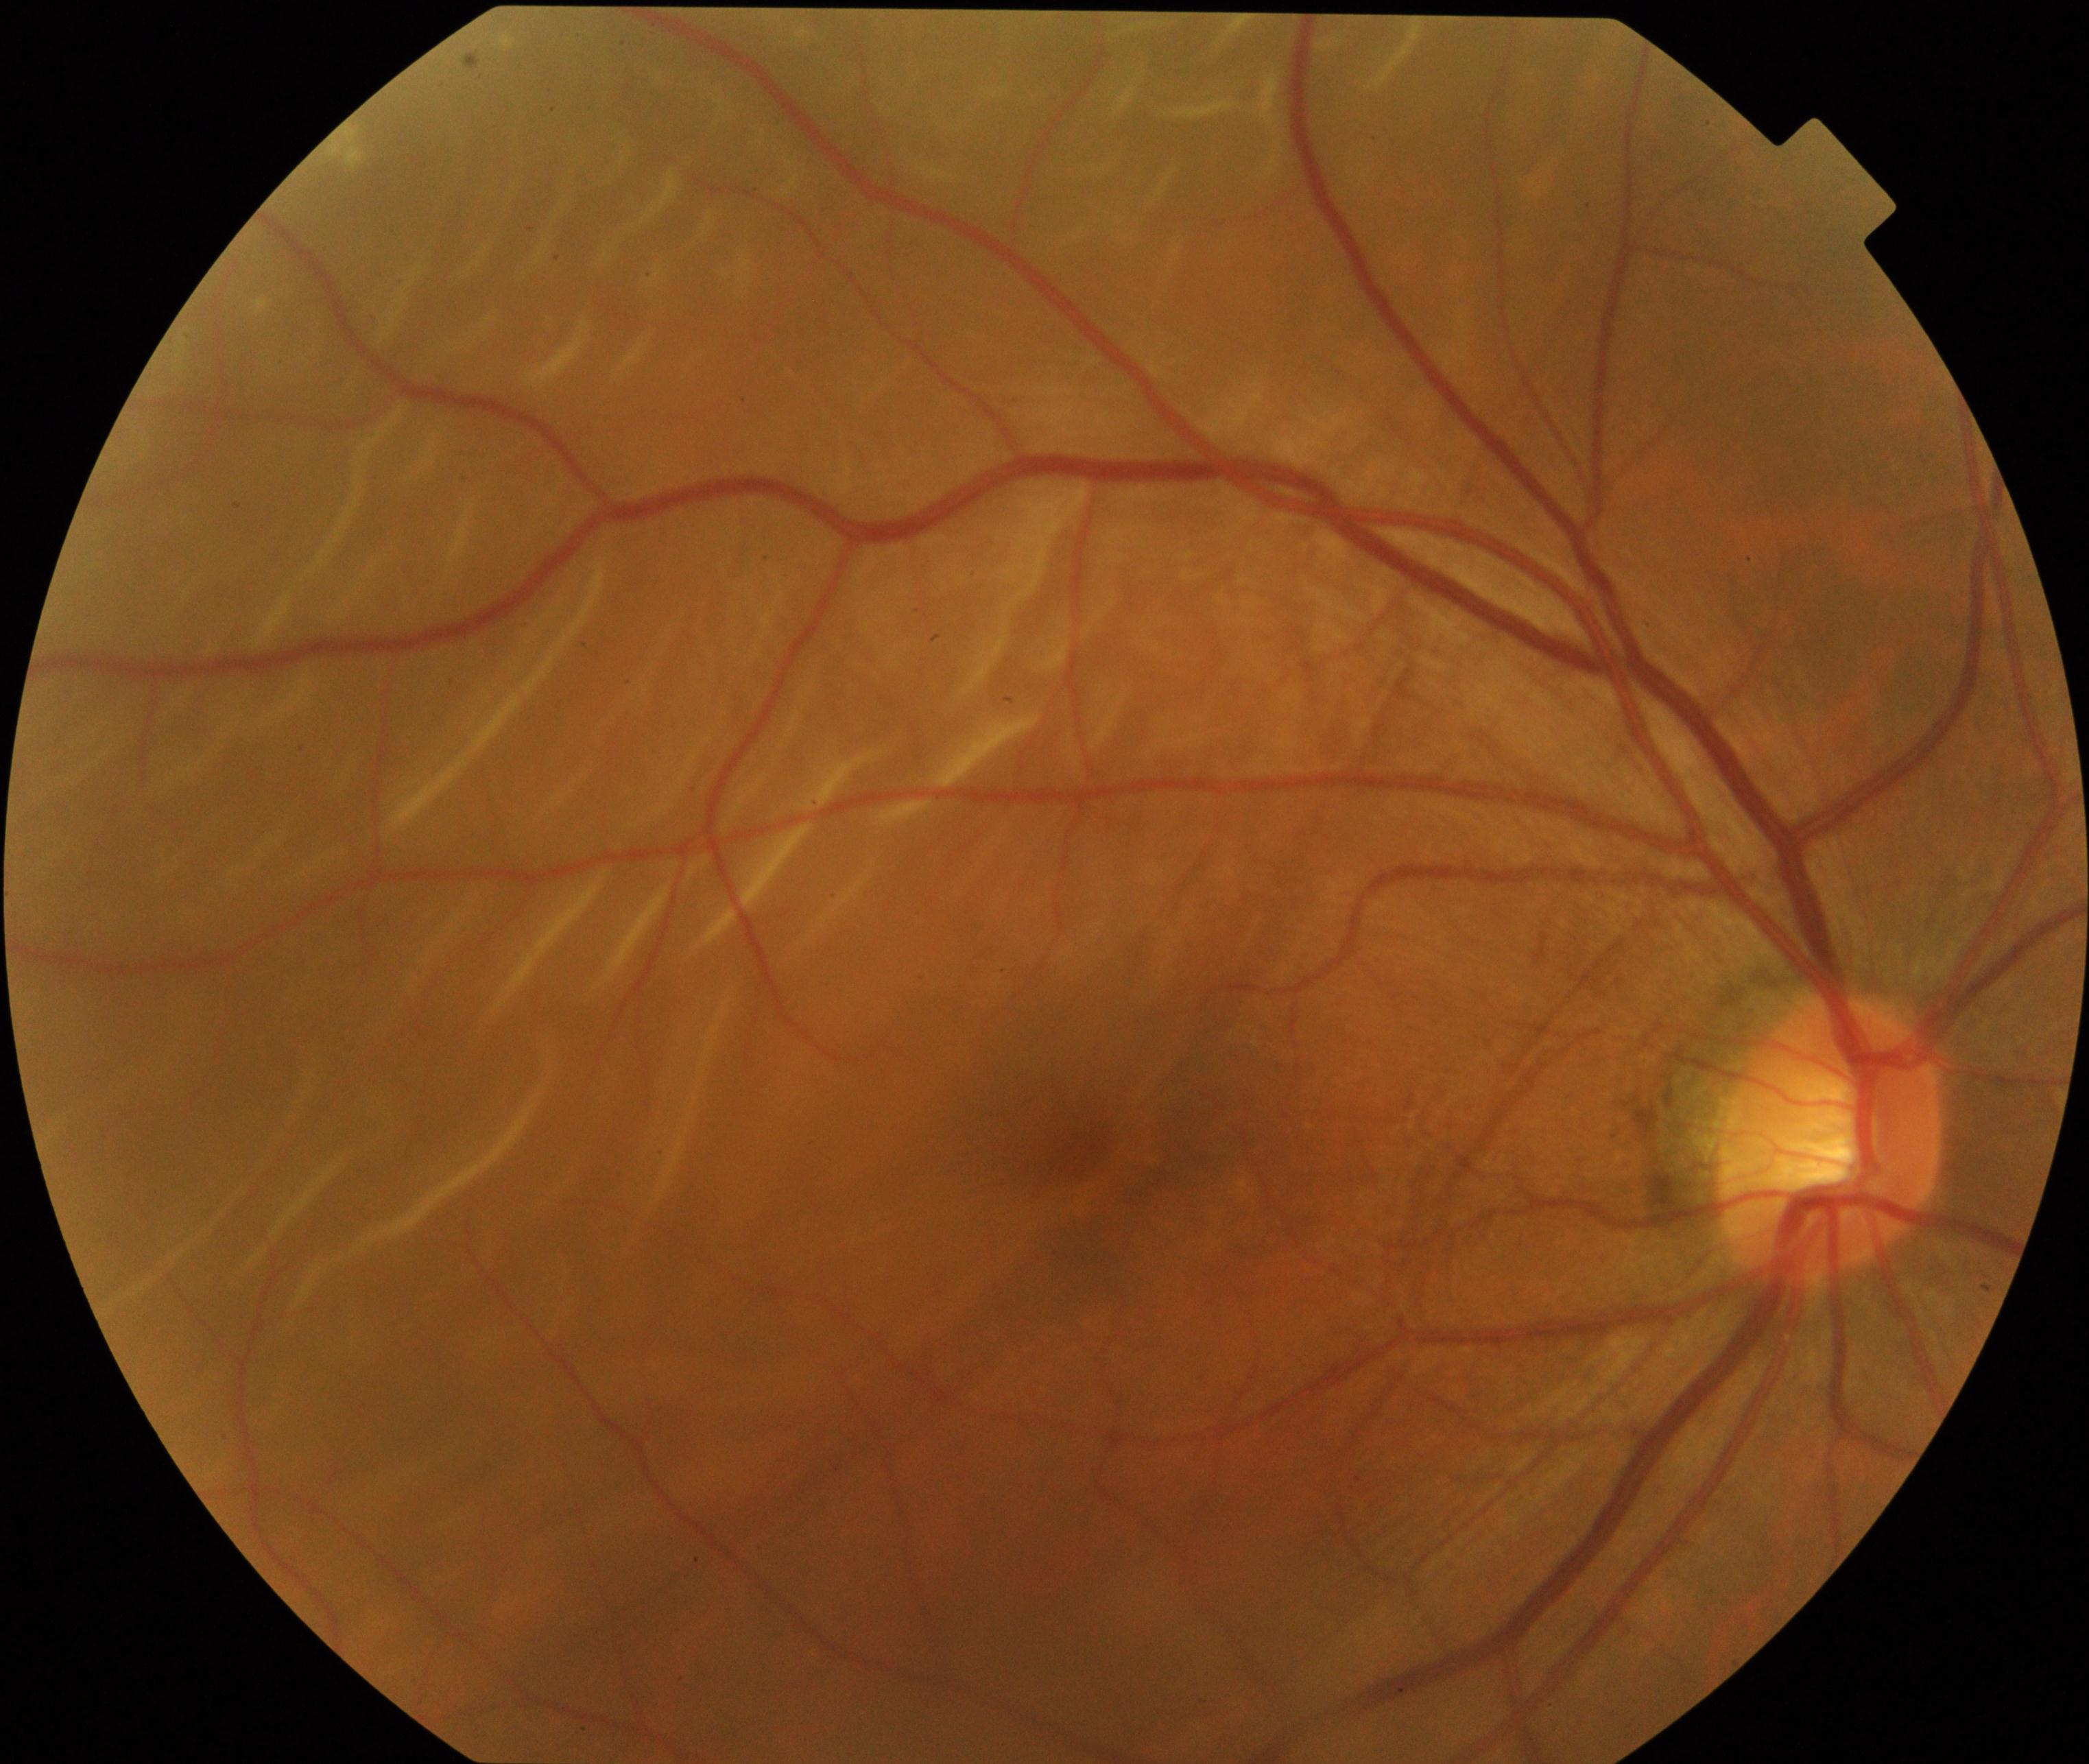 Consistent with rhegmatogenous retinal detachment.